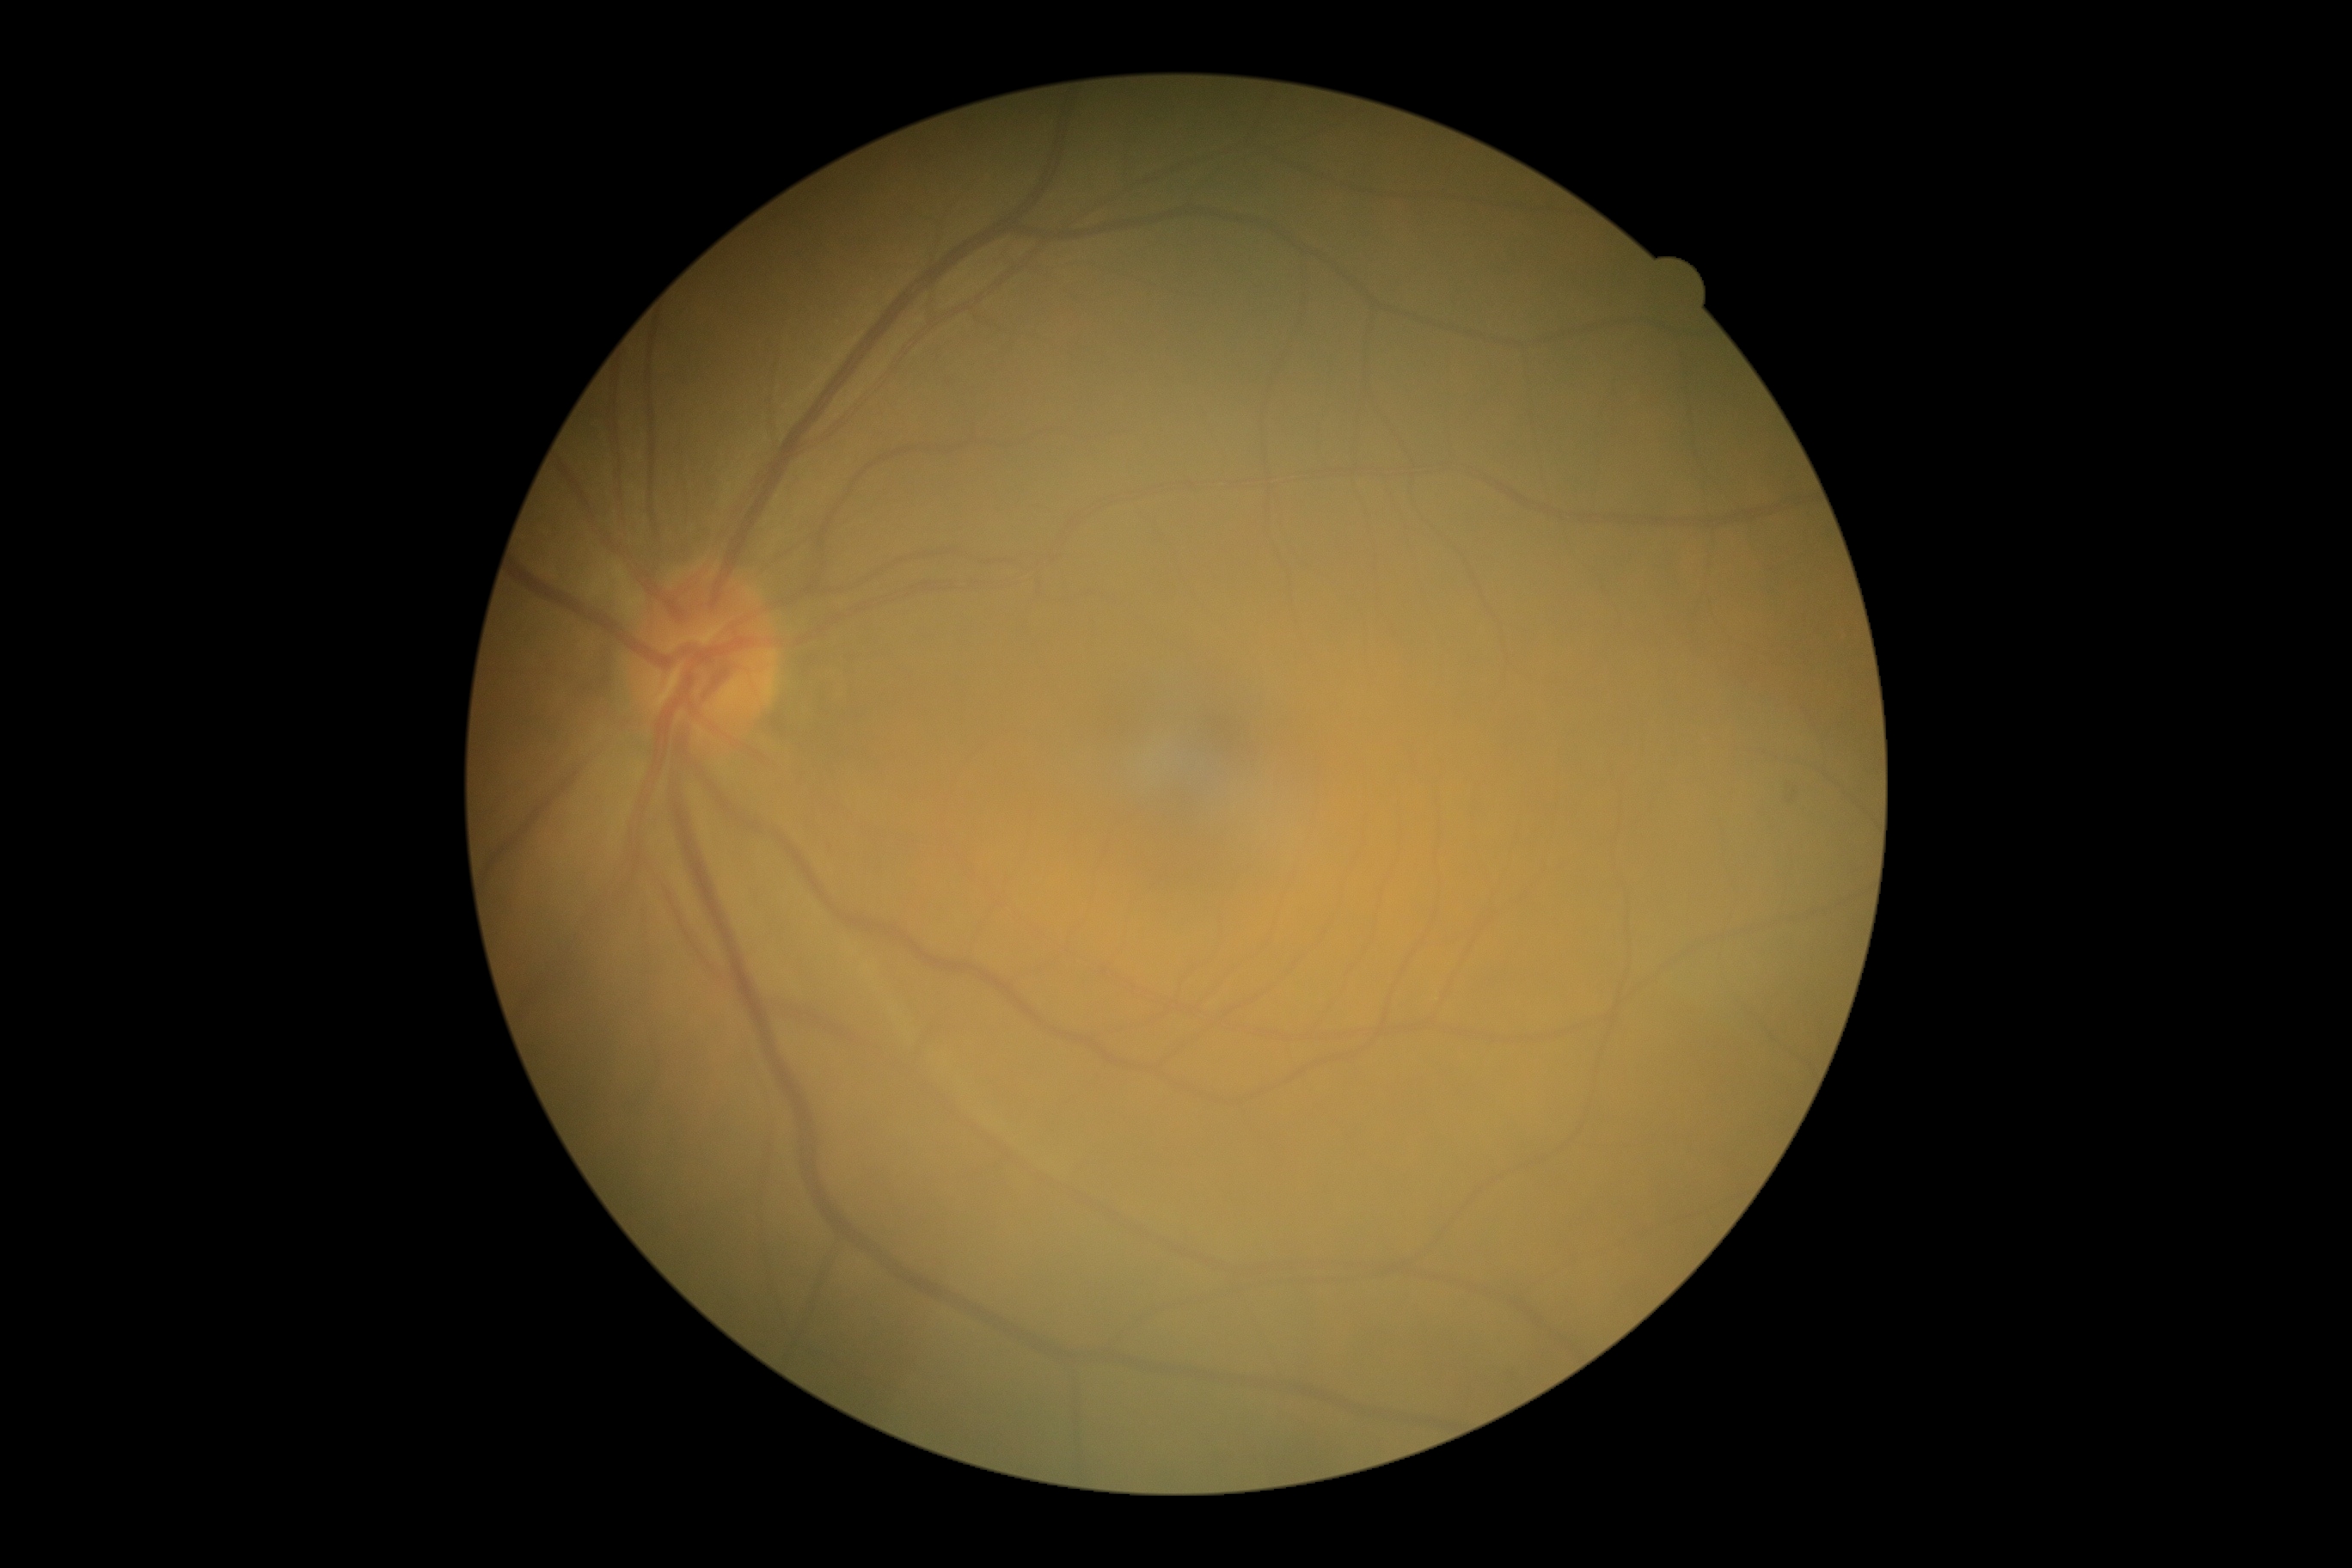 diabetic retinopathy (DR): grade 0.